CFP, captured after pupil dilation — 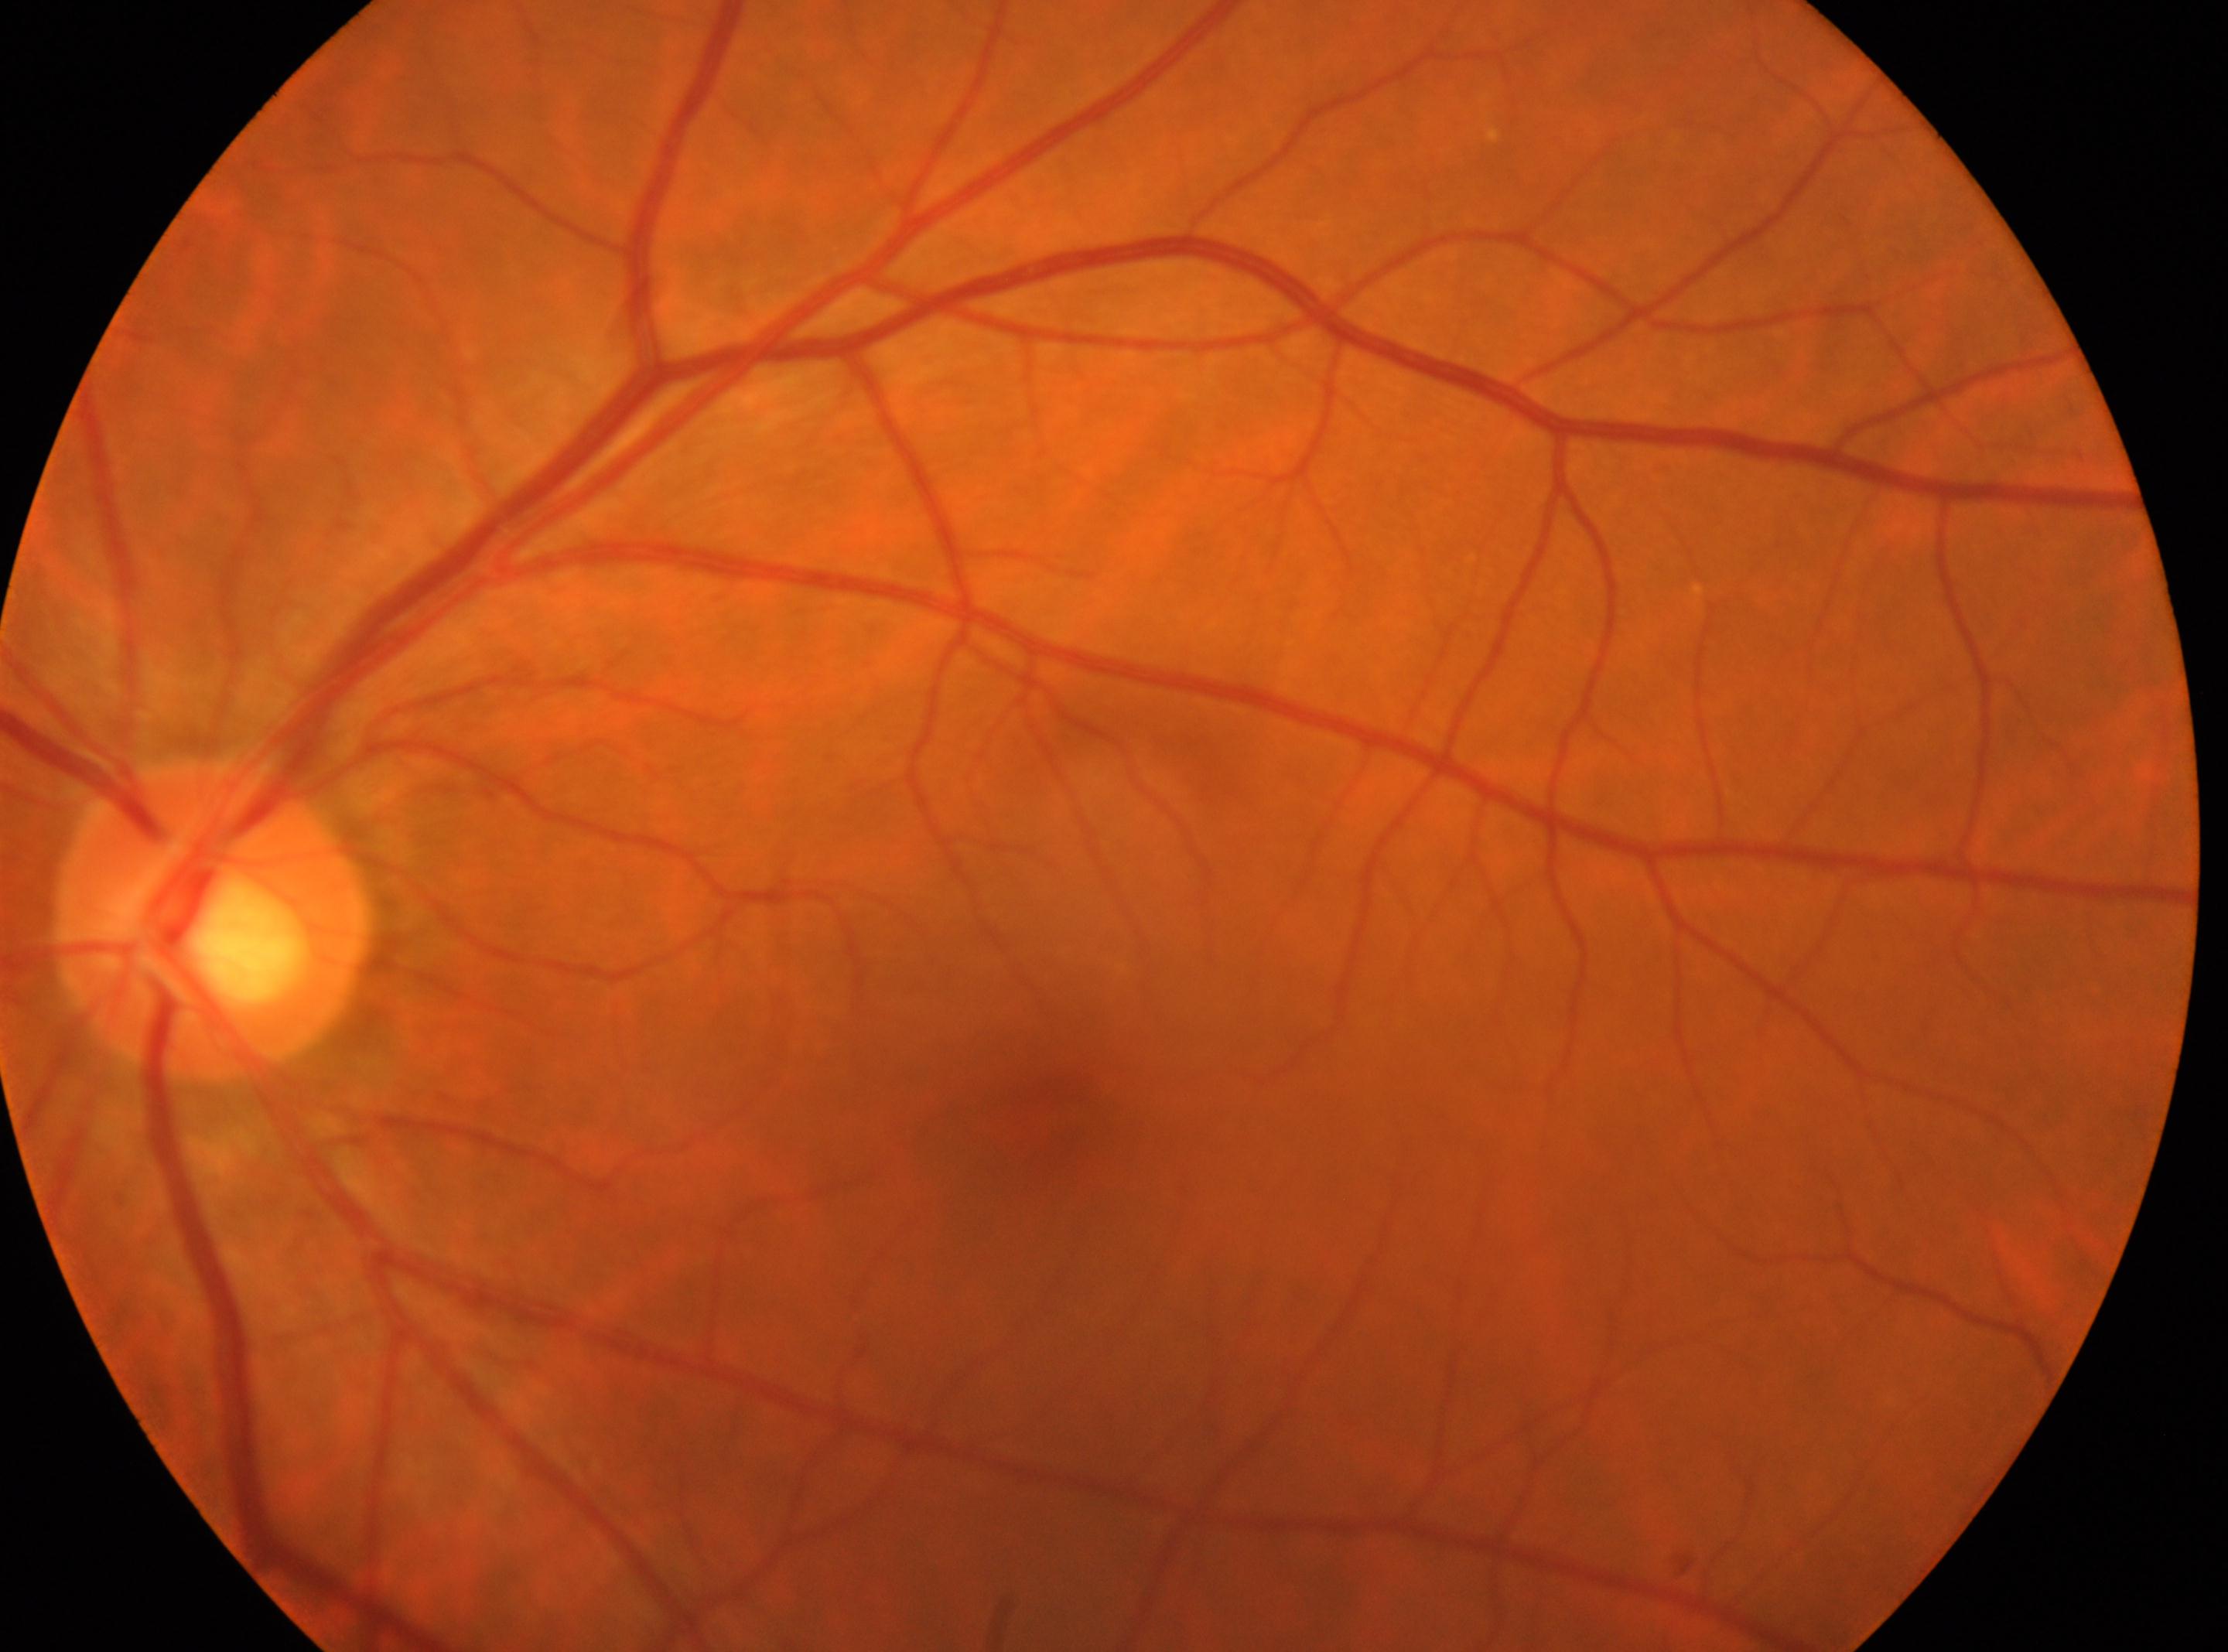

laterality = oculus sinister | optic nerve head = x=210, y=917 | diabetic retinopathy (DR) = 0 — no visible signs of diabetic retinopathy | fovea center = x=1037, y=1121.